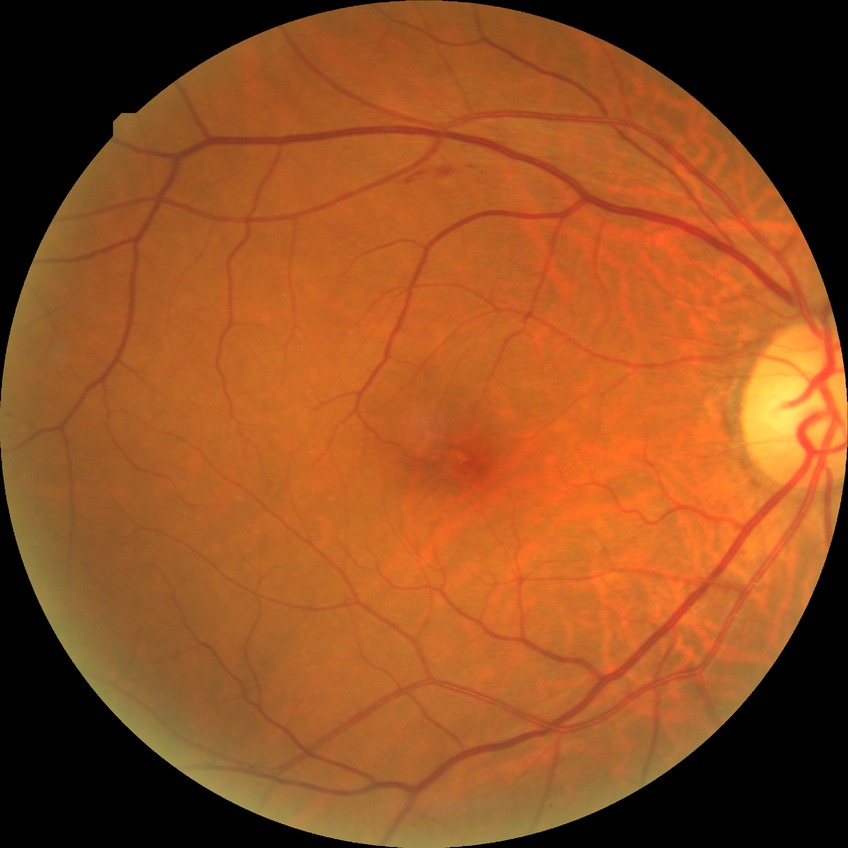 {"davis_grade": "NDR (no diabetic retinopathy)"}